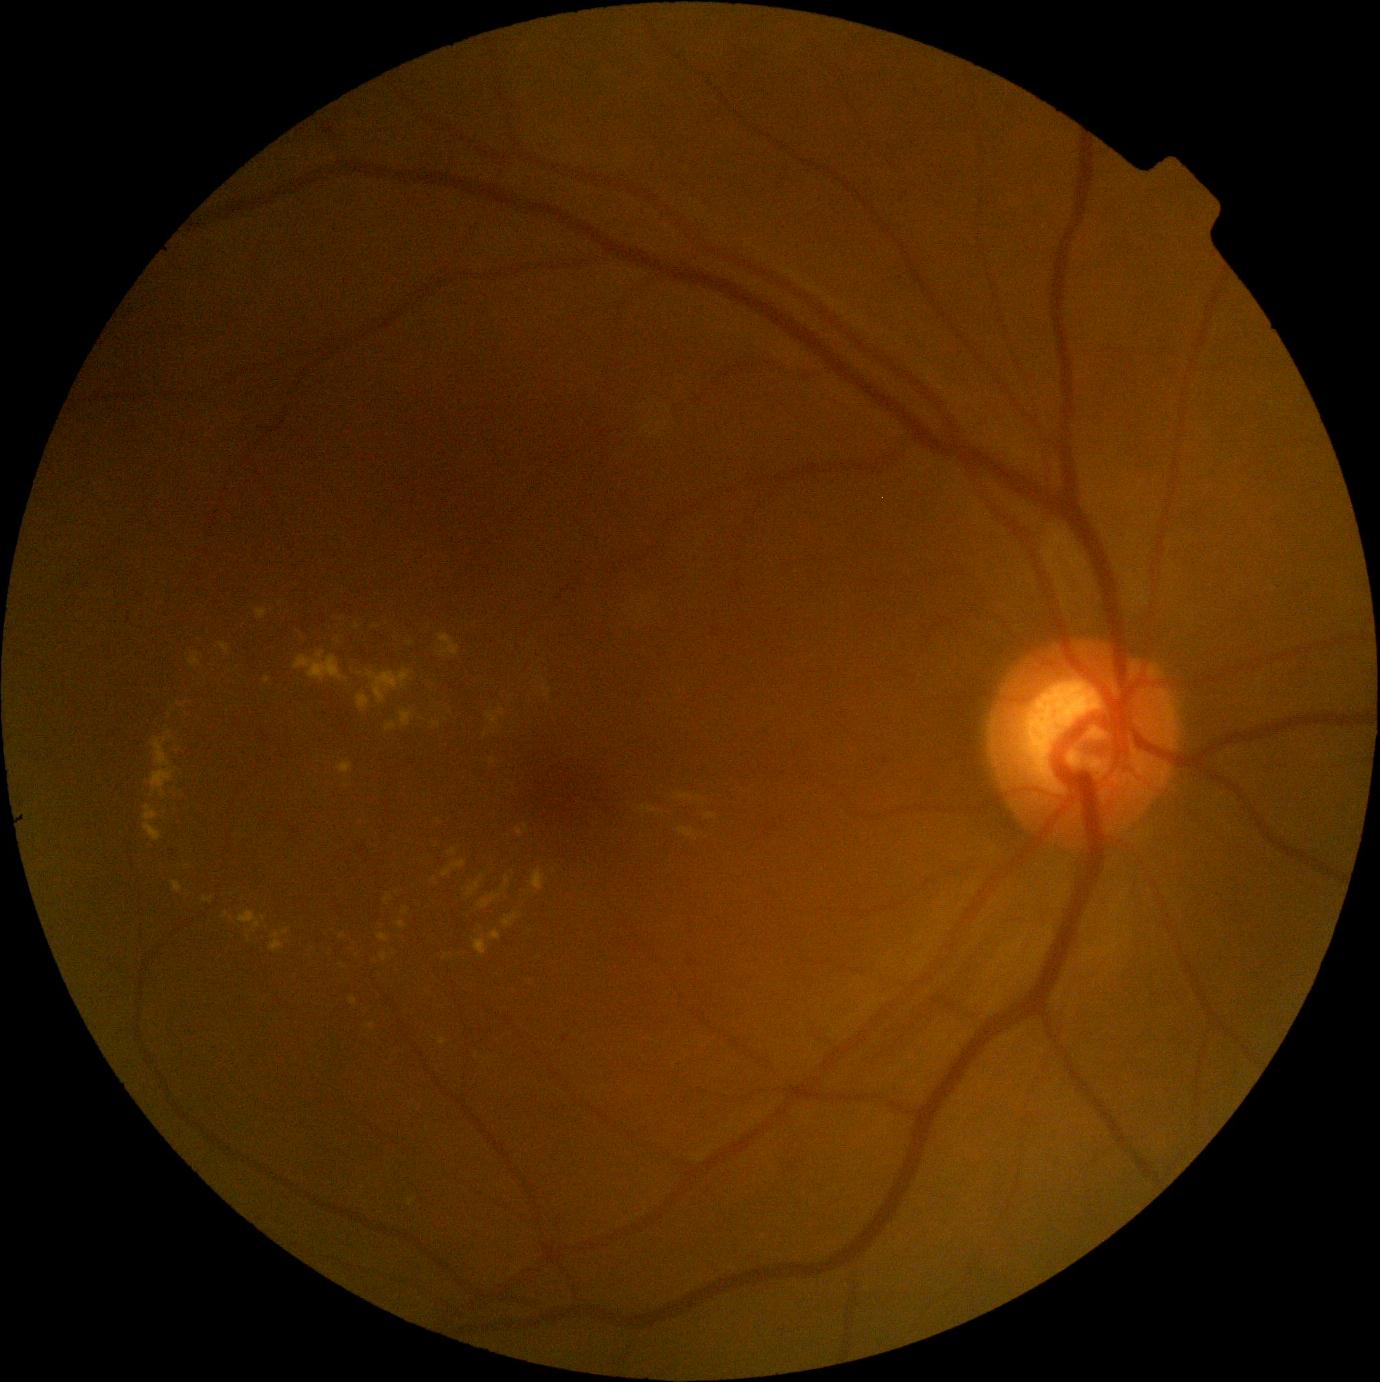 DR class: non-proliferative diabetic retinopathy.
DR severity: grade 2.